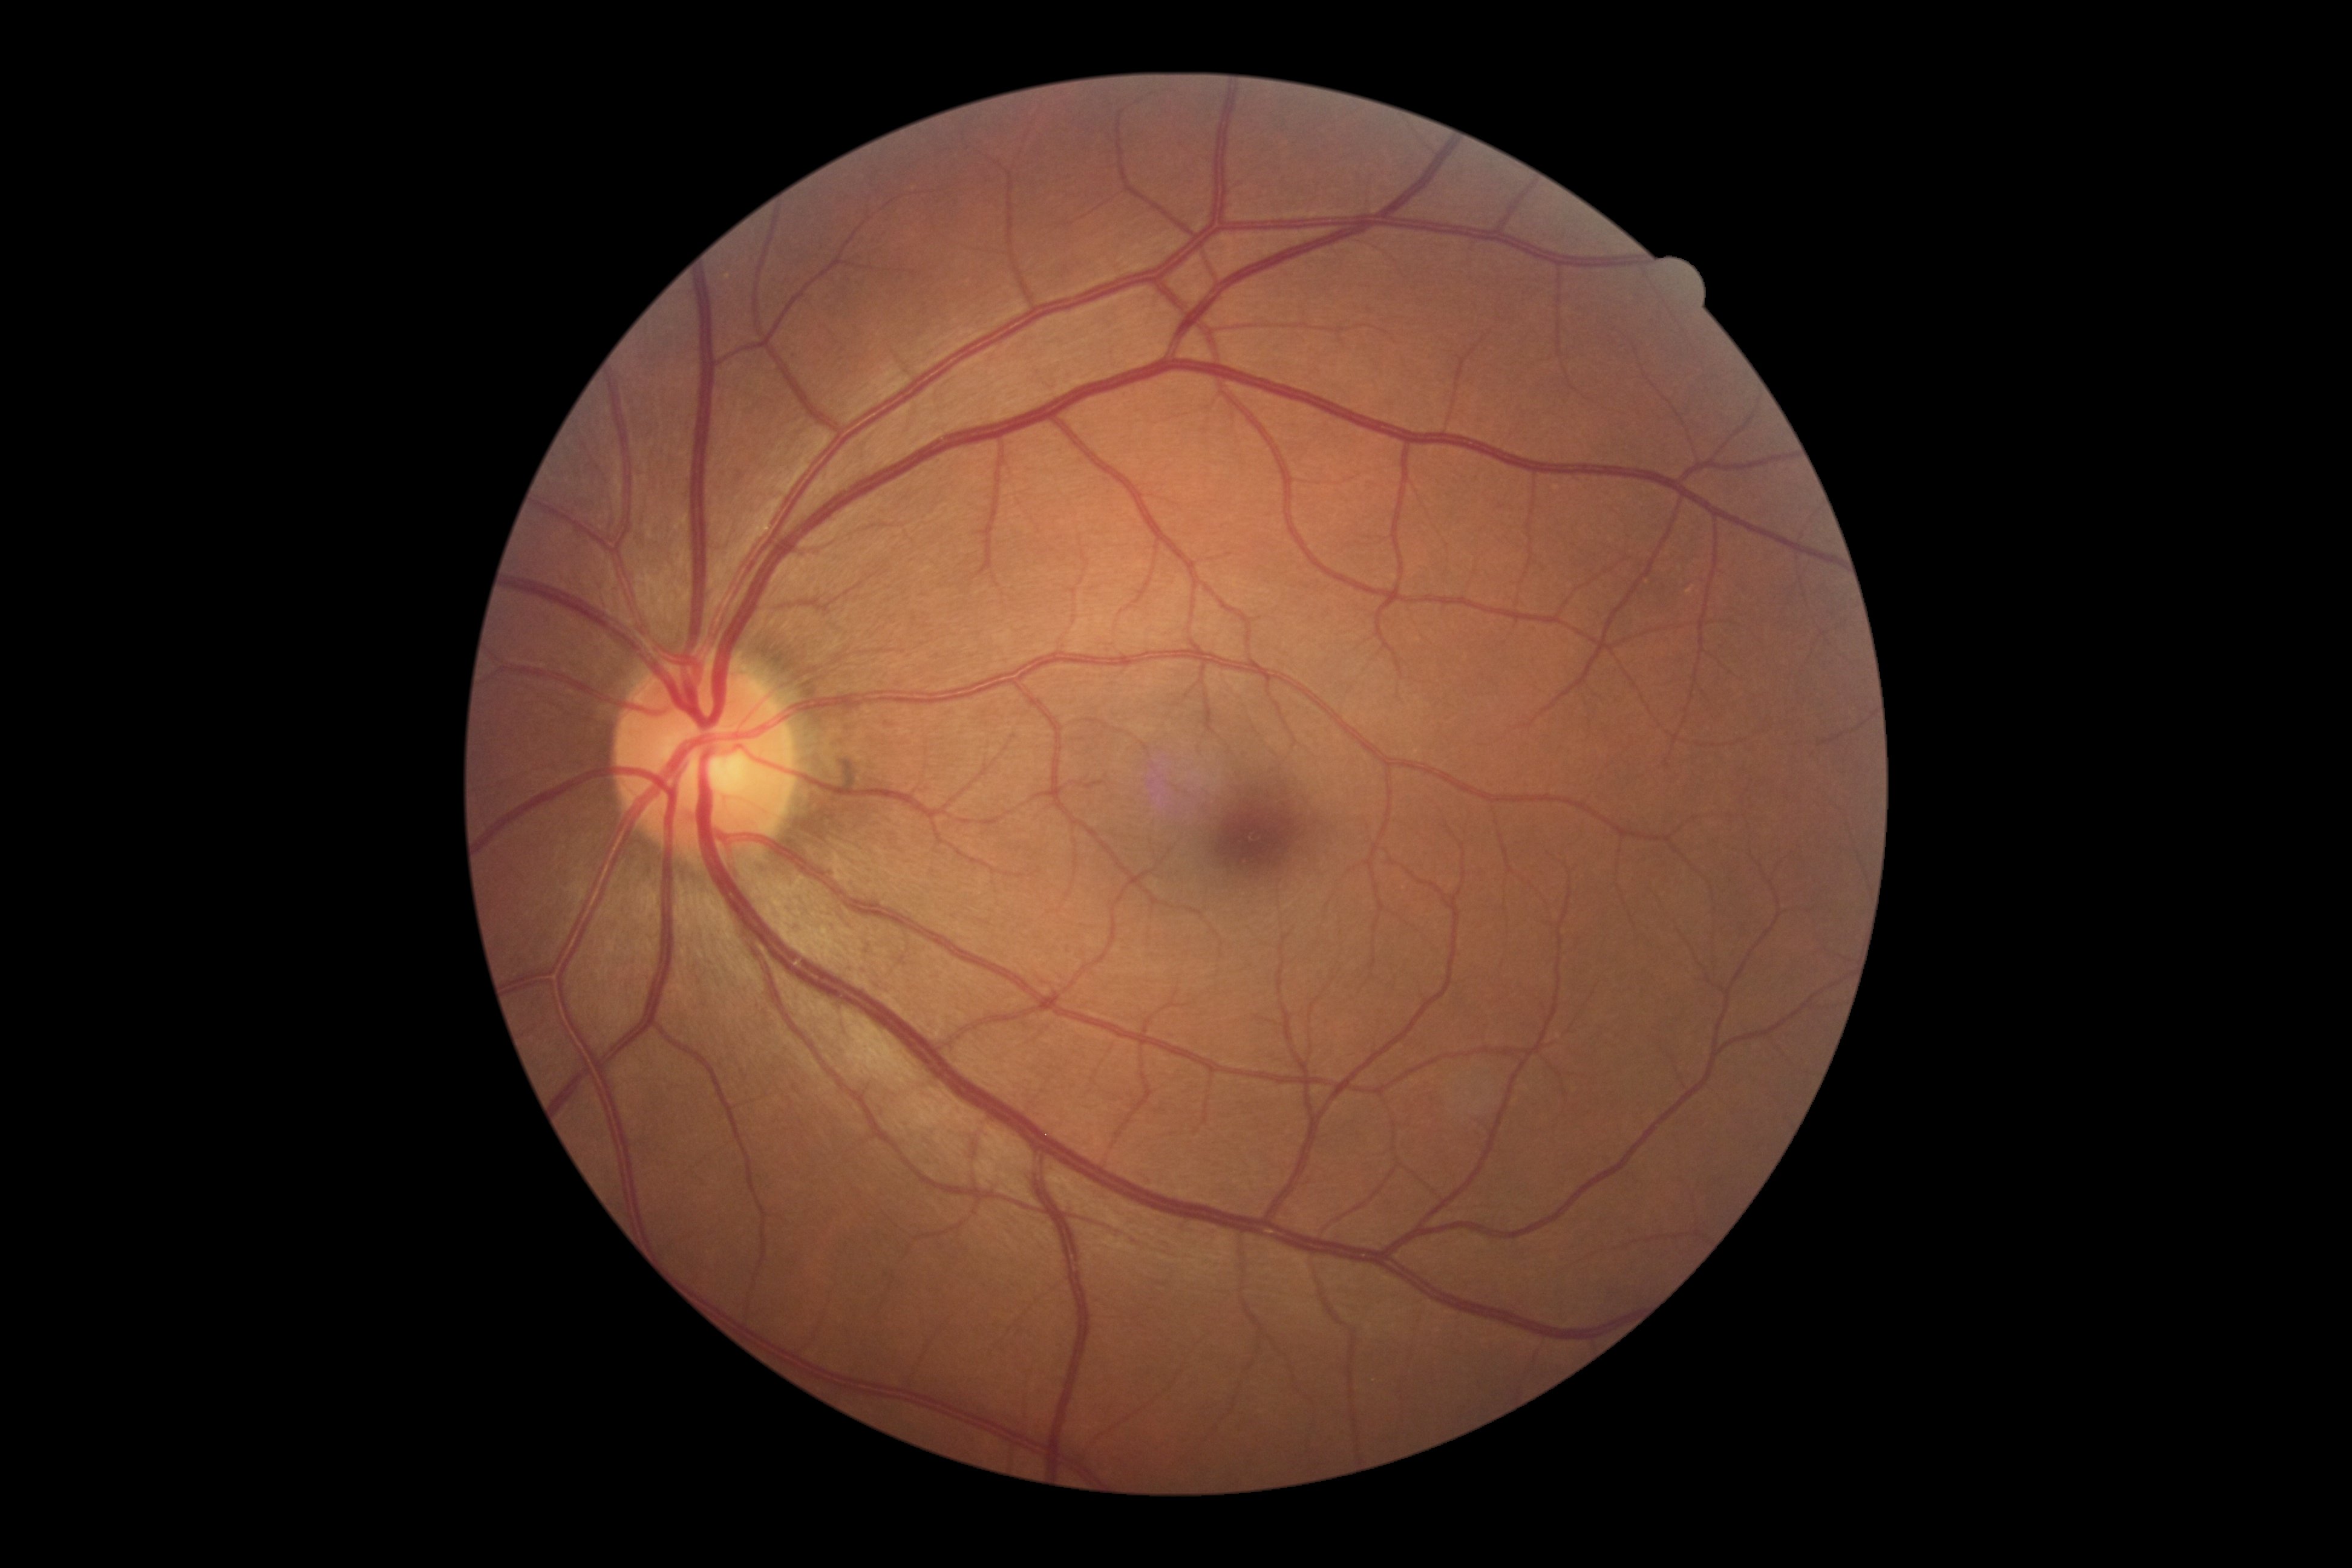
DR stage: no apparent diabetic retinopathy (grade 0).